Pediatric wide-field fundus photograph — 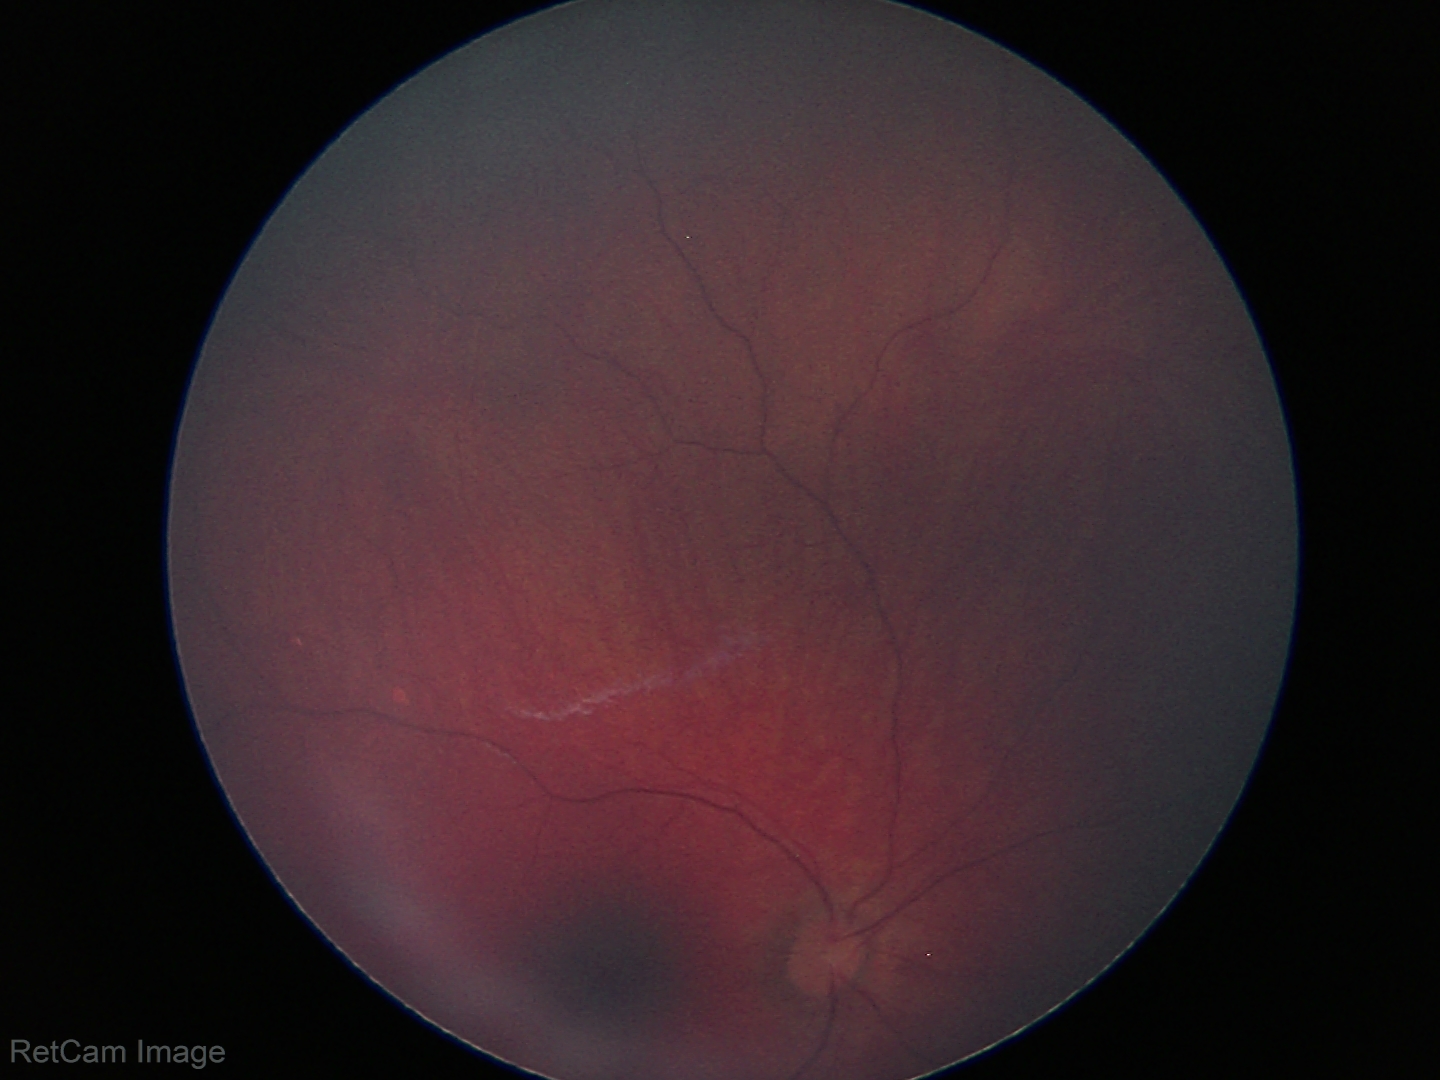

Screening examination with no abnormal retinal findings.